Image size 2352x1568, 45° FOV: 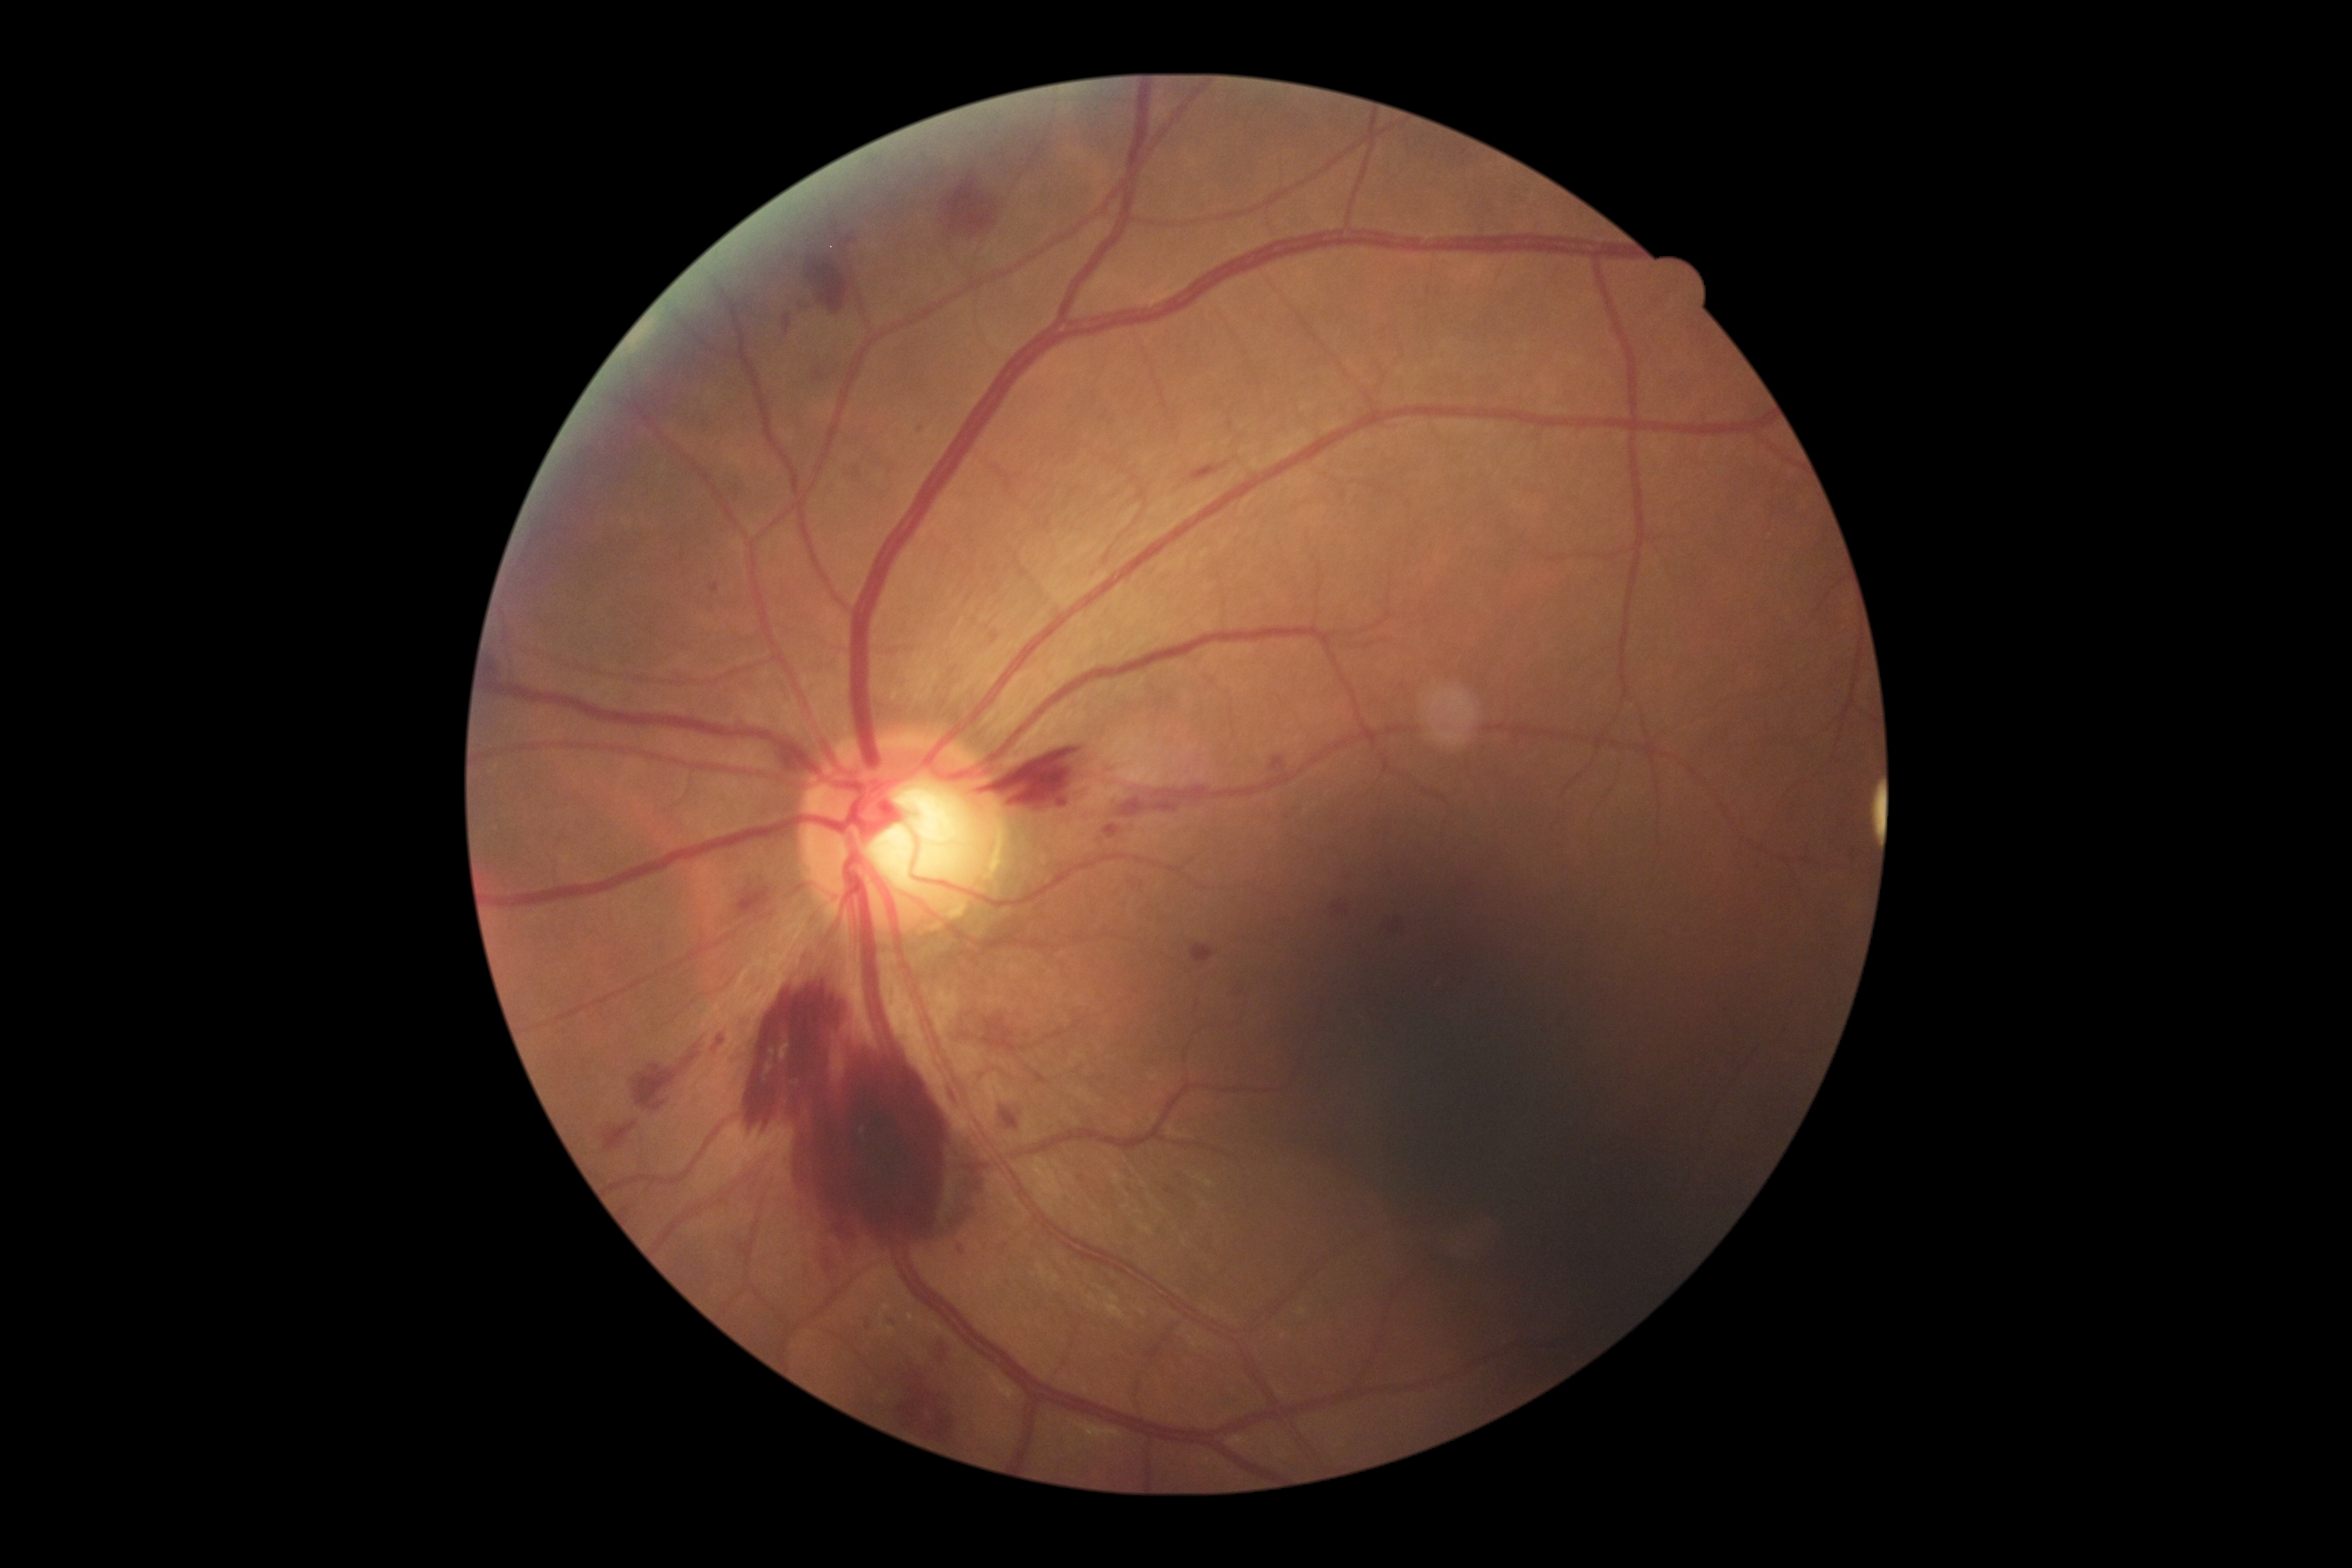
• DR — 4/4